Wide-field fundus photograph from neonatal ROP screening · image size 640x480:
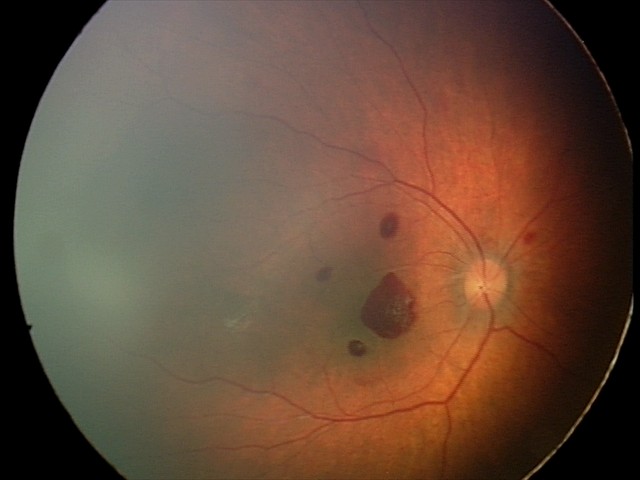

Impression = retinal hemorrhages